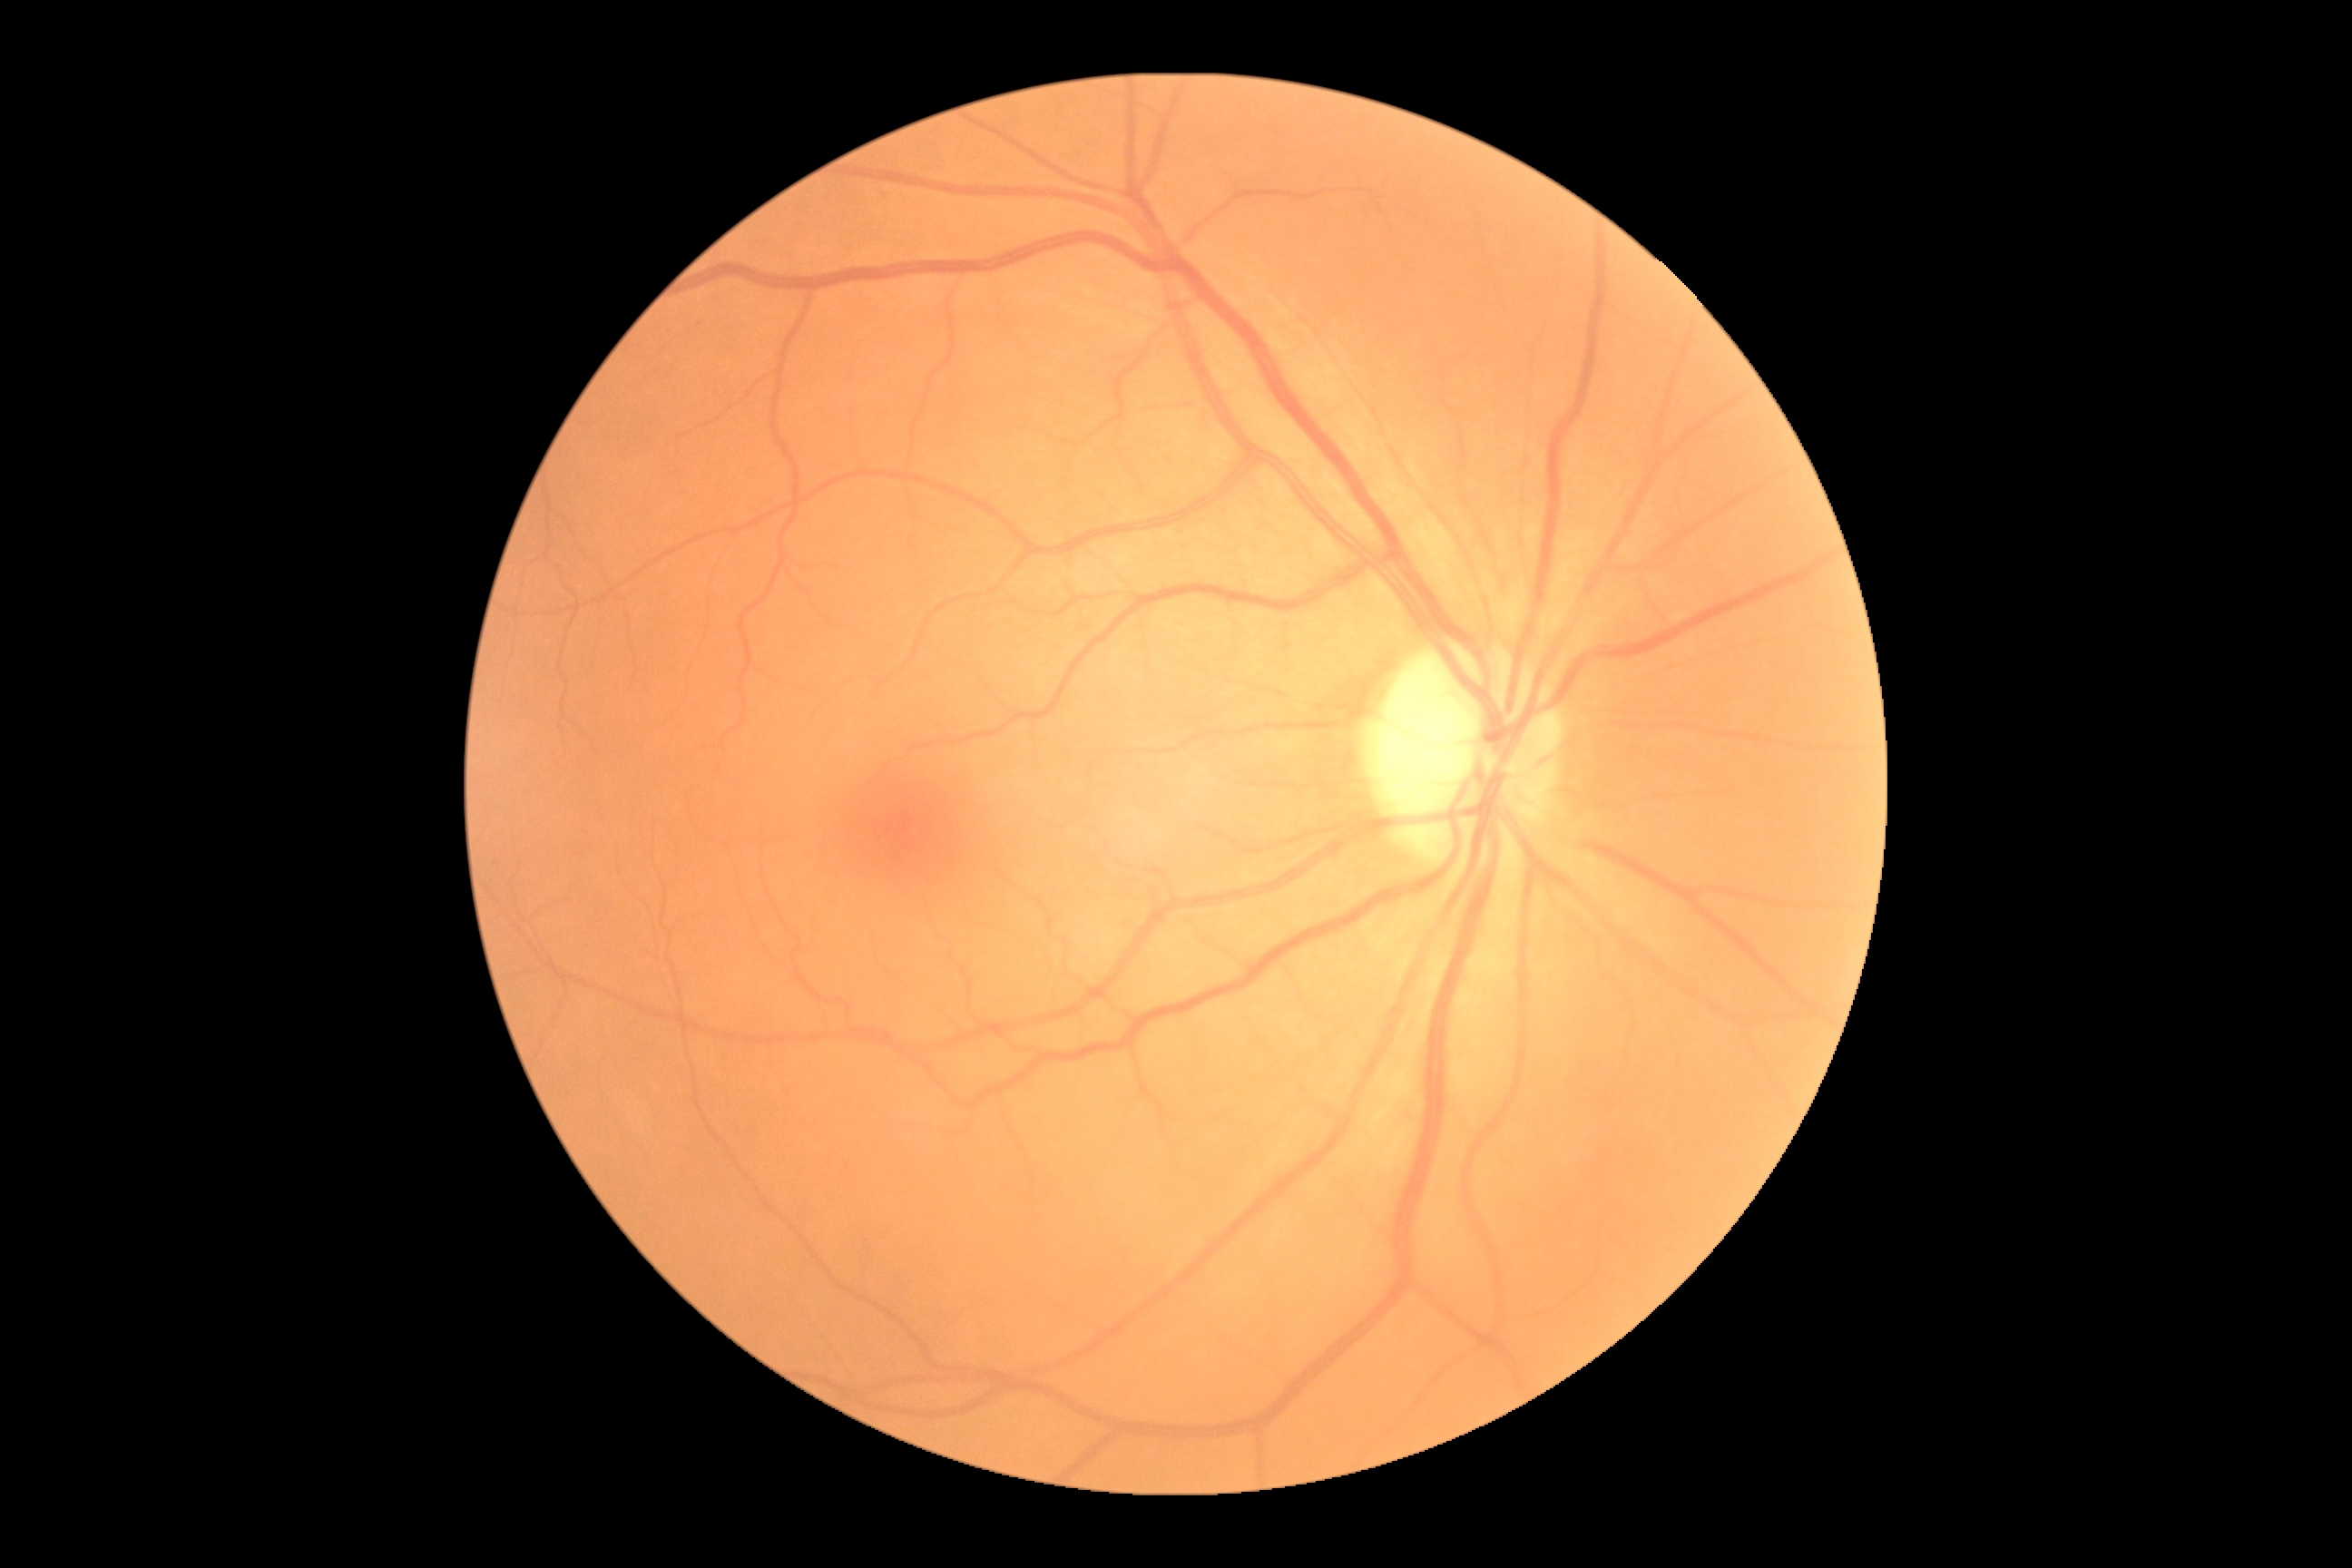
Diabetic retinopathy is grade 0 (no apparent retinopathy) — no visible signs of diabetic retinopathy.